45° FOV.
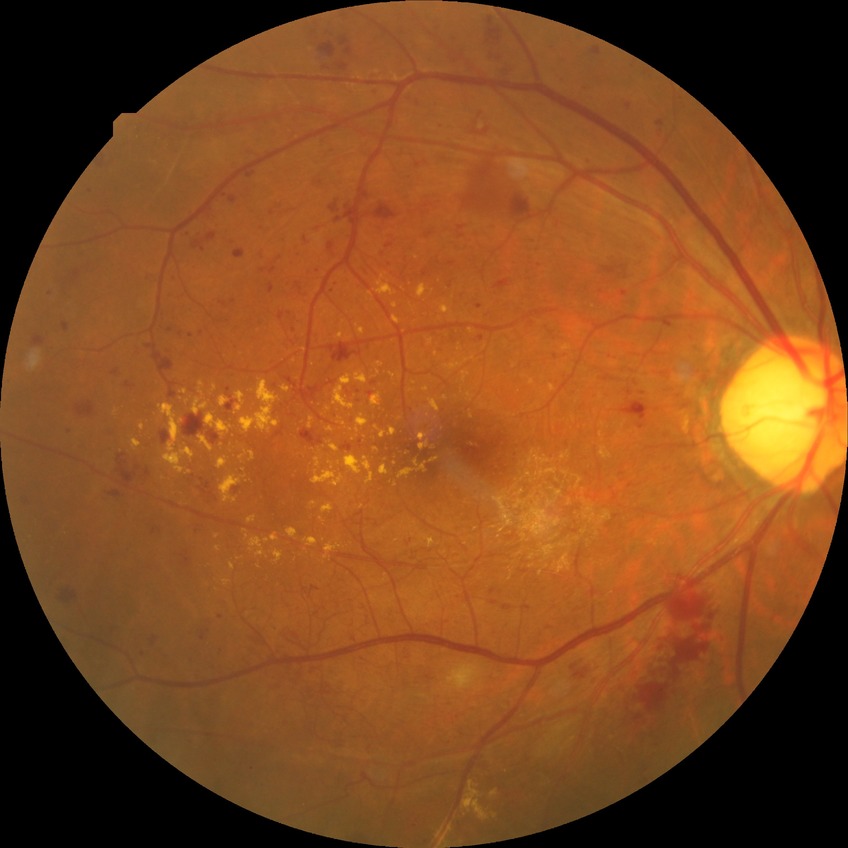 {"davis_grade": "SDR (simple diabetic retinopathy)"}